Image size 2102x1736 — 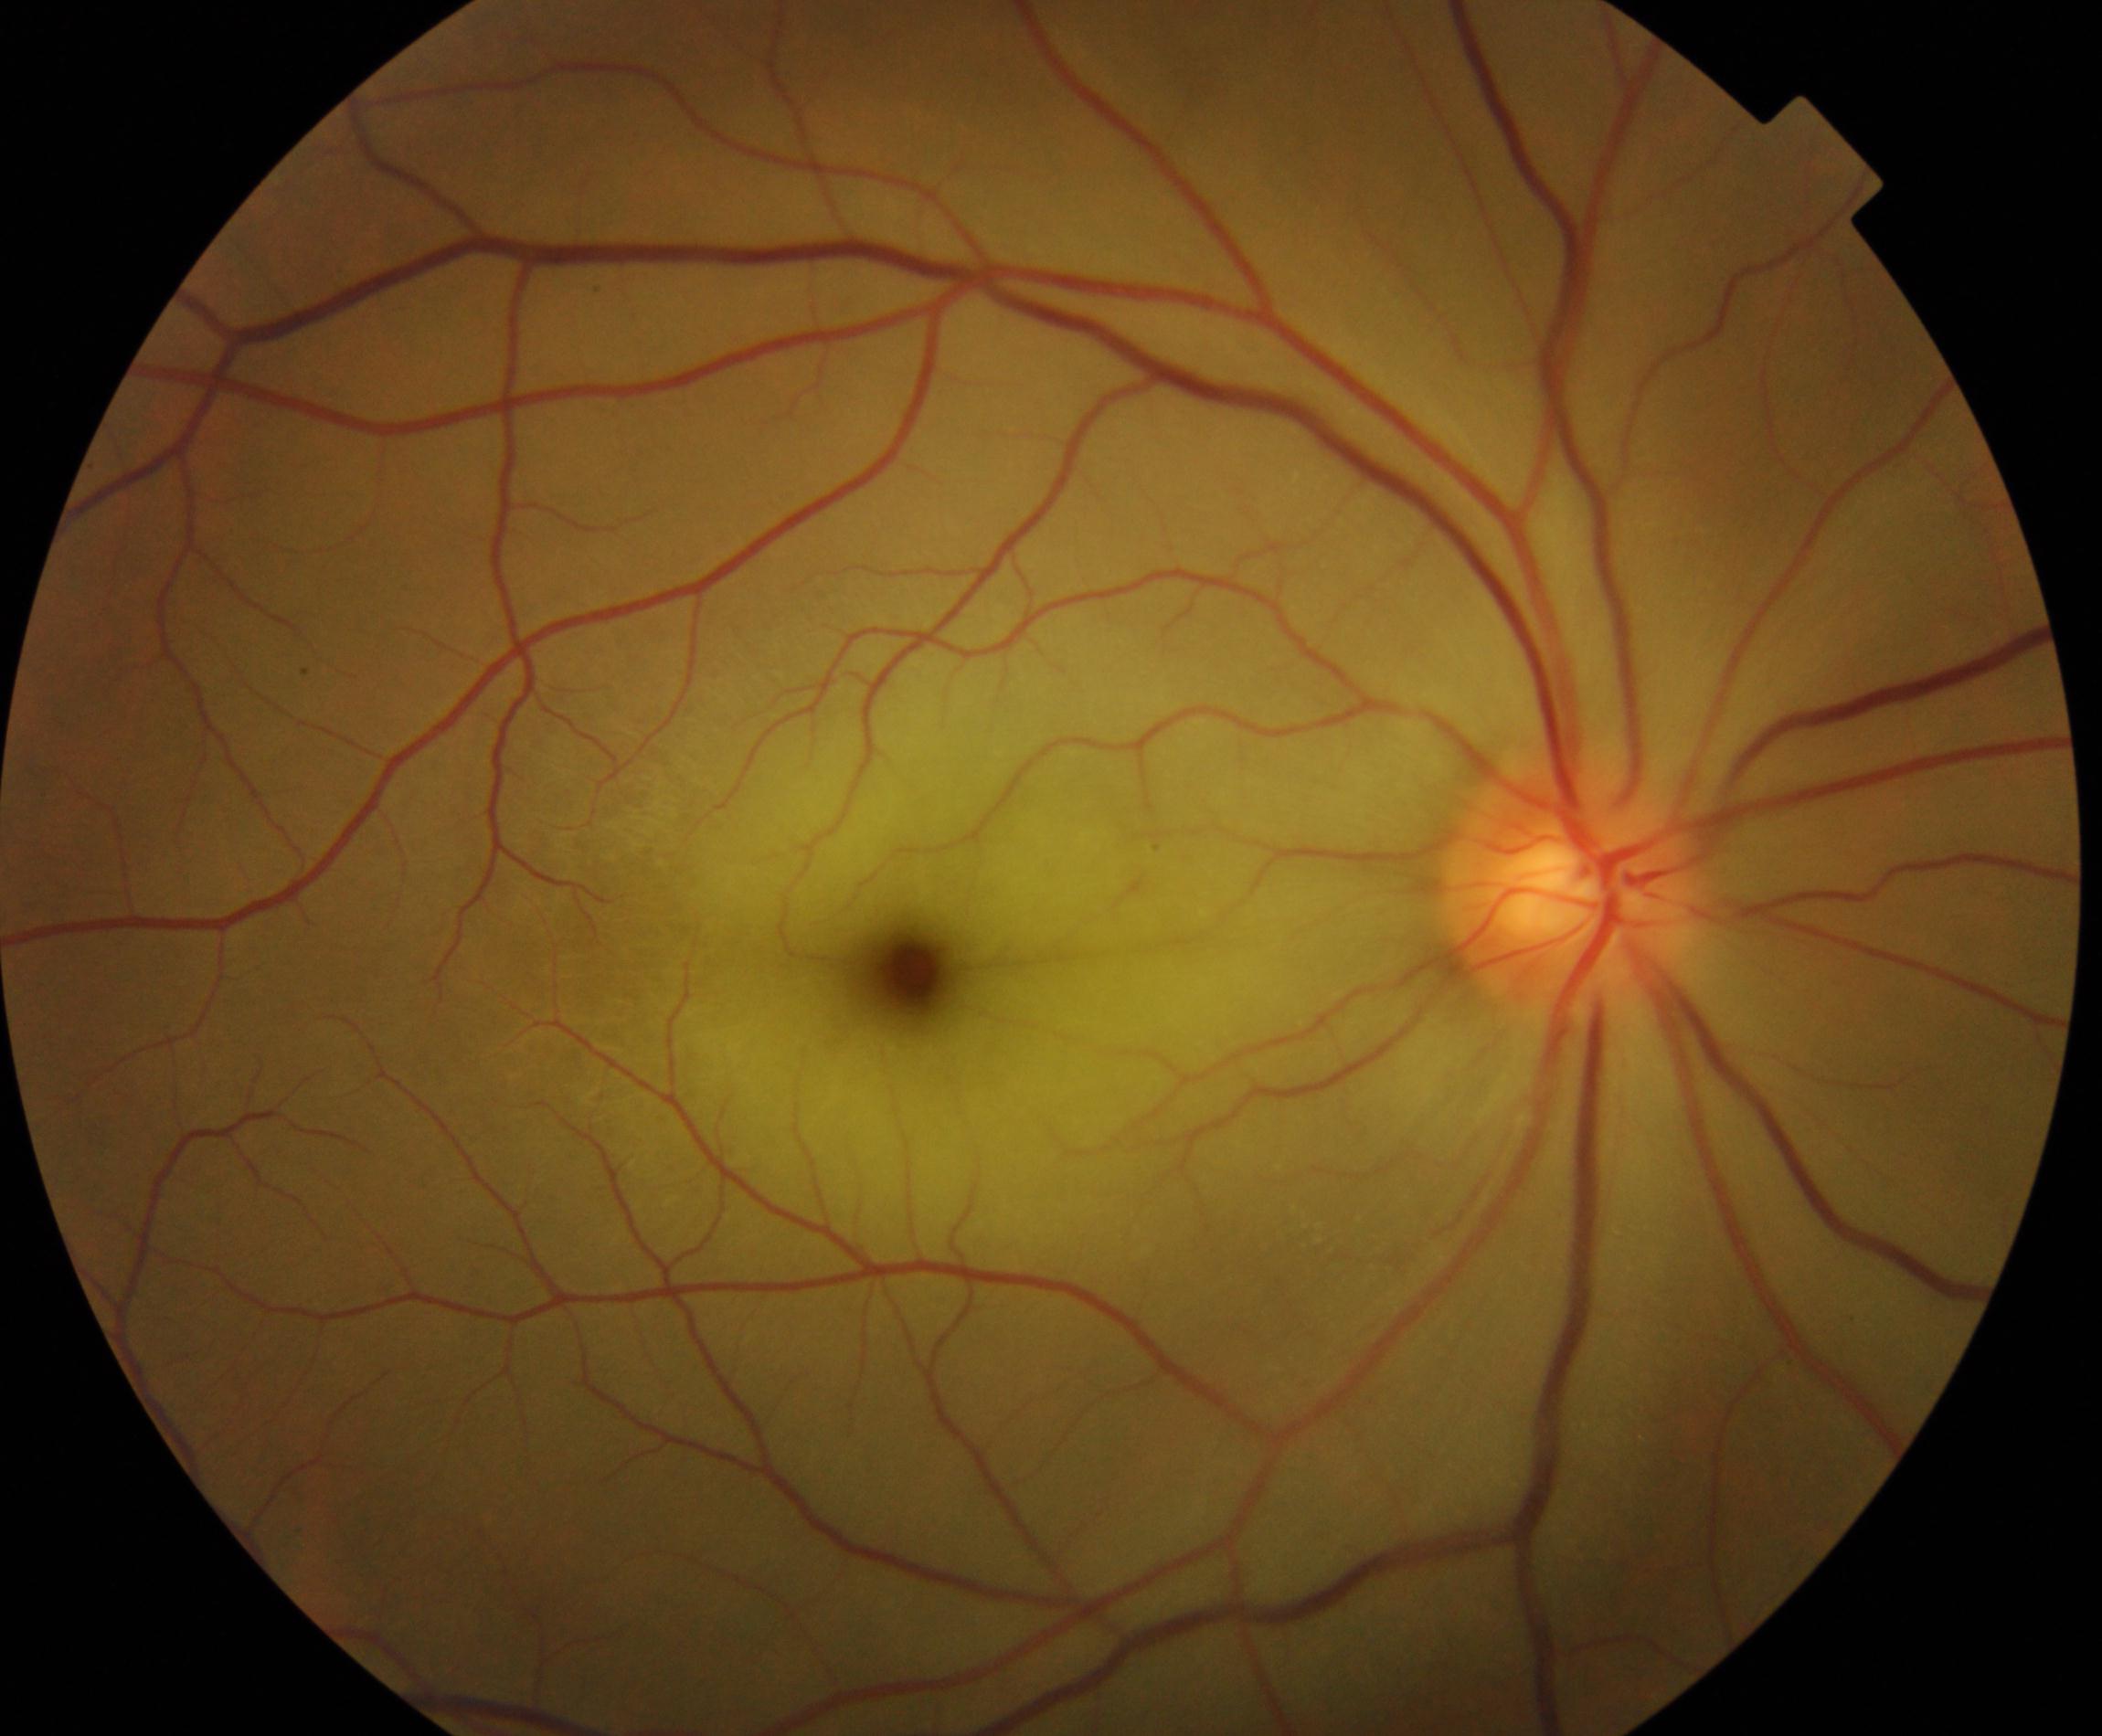

Findings: retinal artery occlusion.